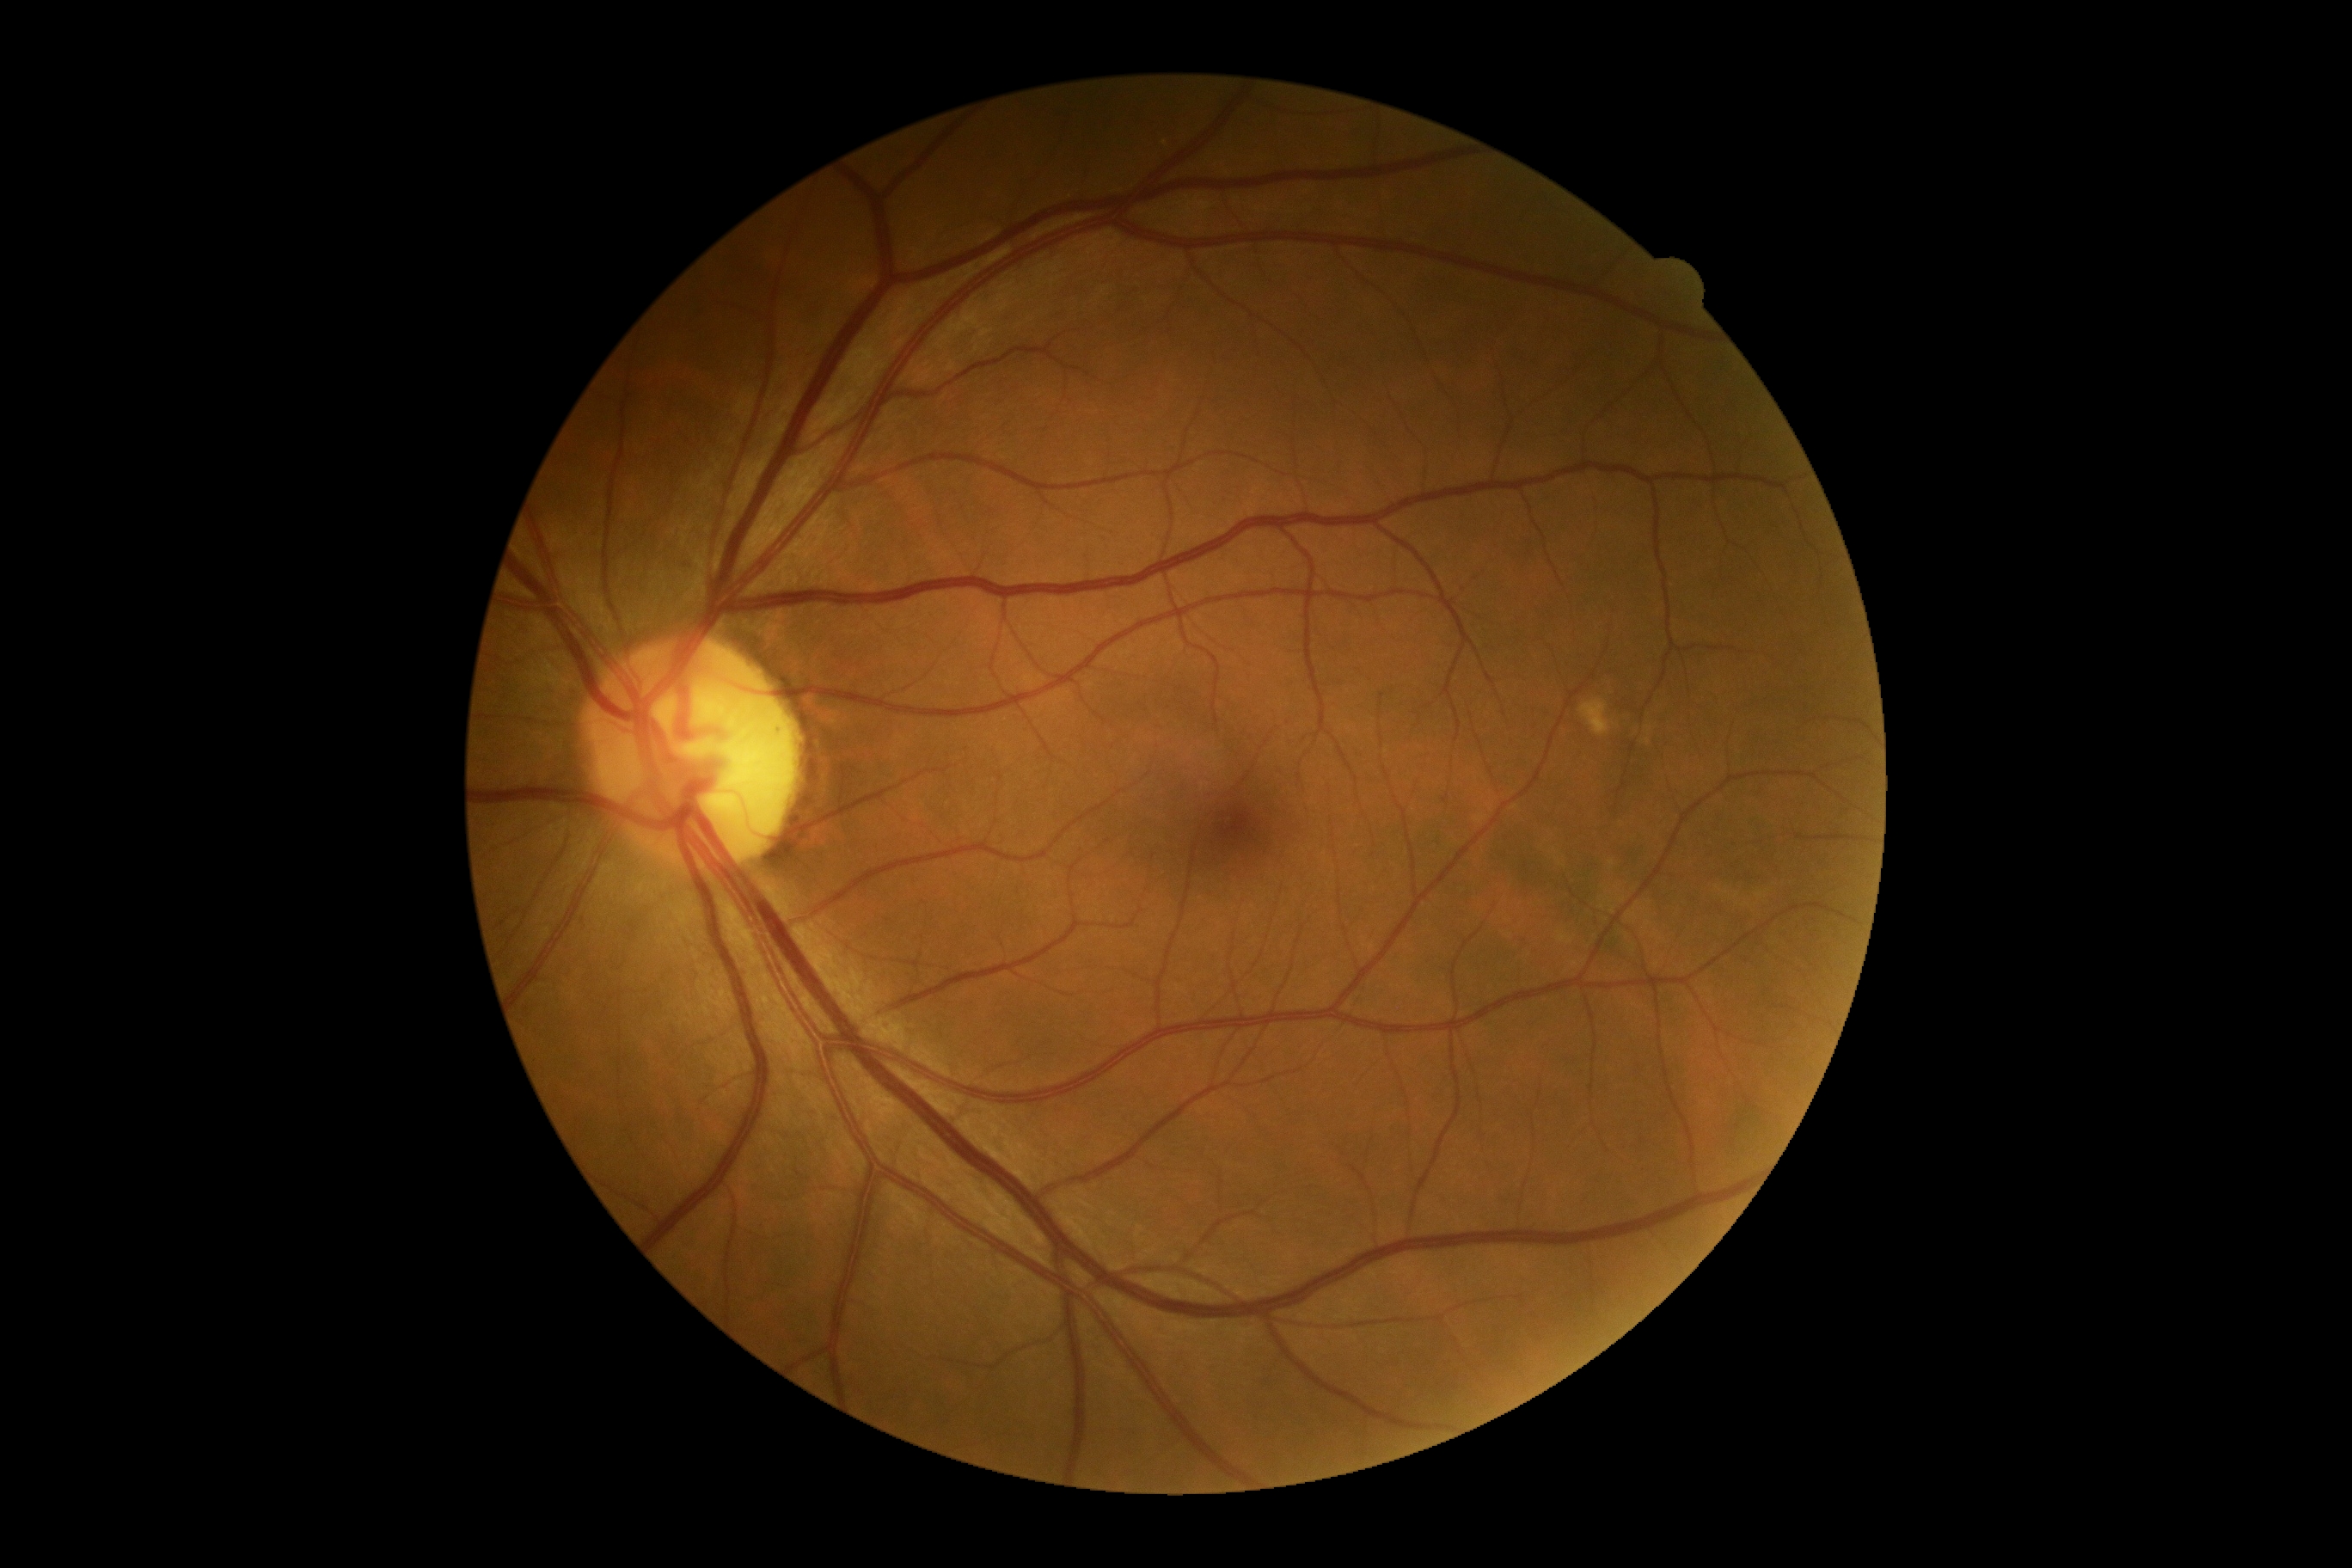 No DR findings. Diabetic retinopathy is no apparent diabetic retinopathy (grade 0).